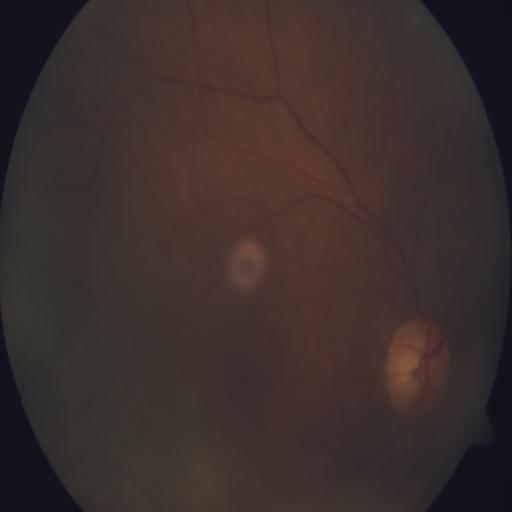

The image shows TD (tilted disc).